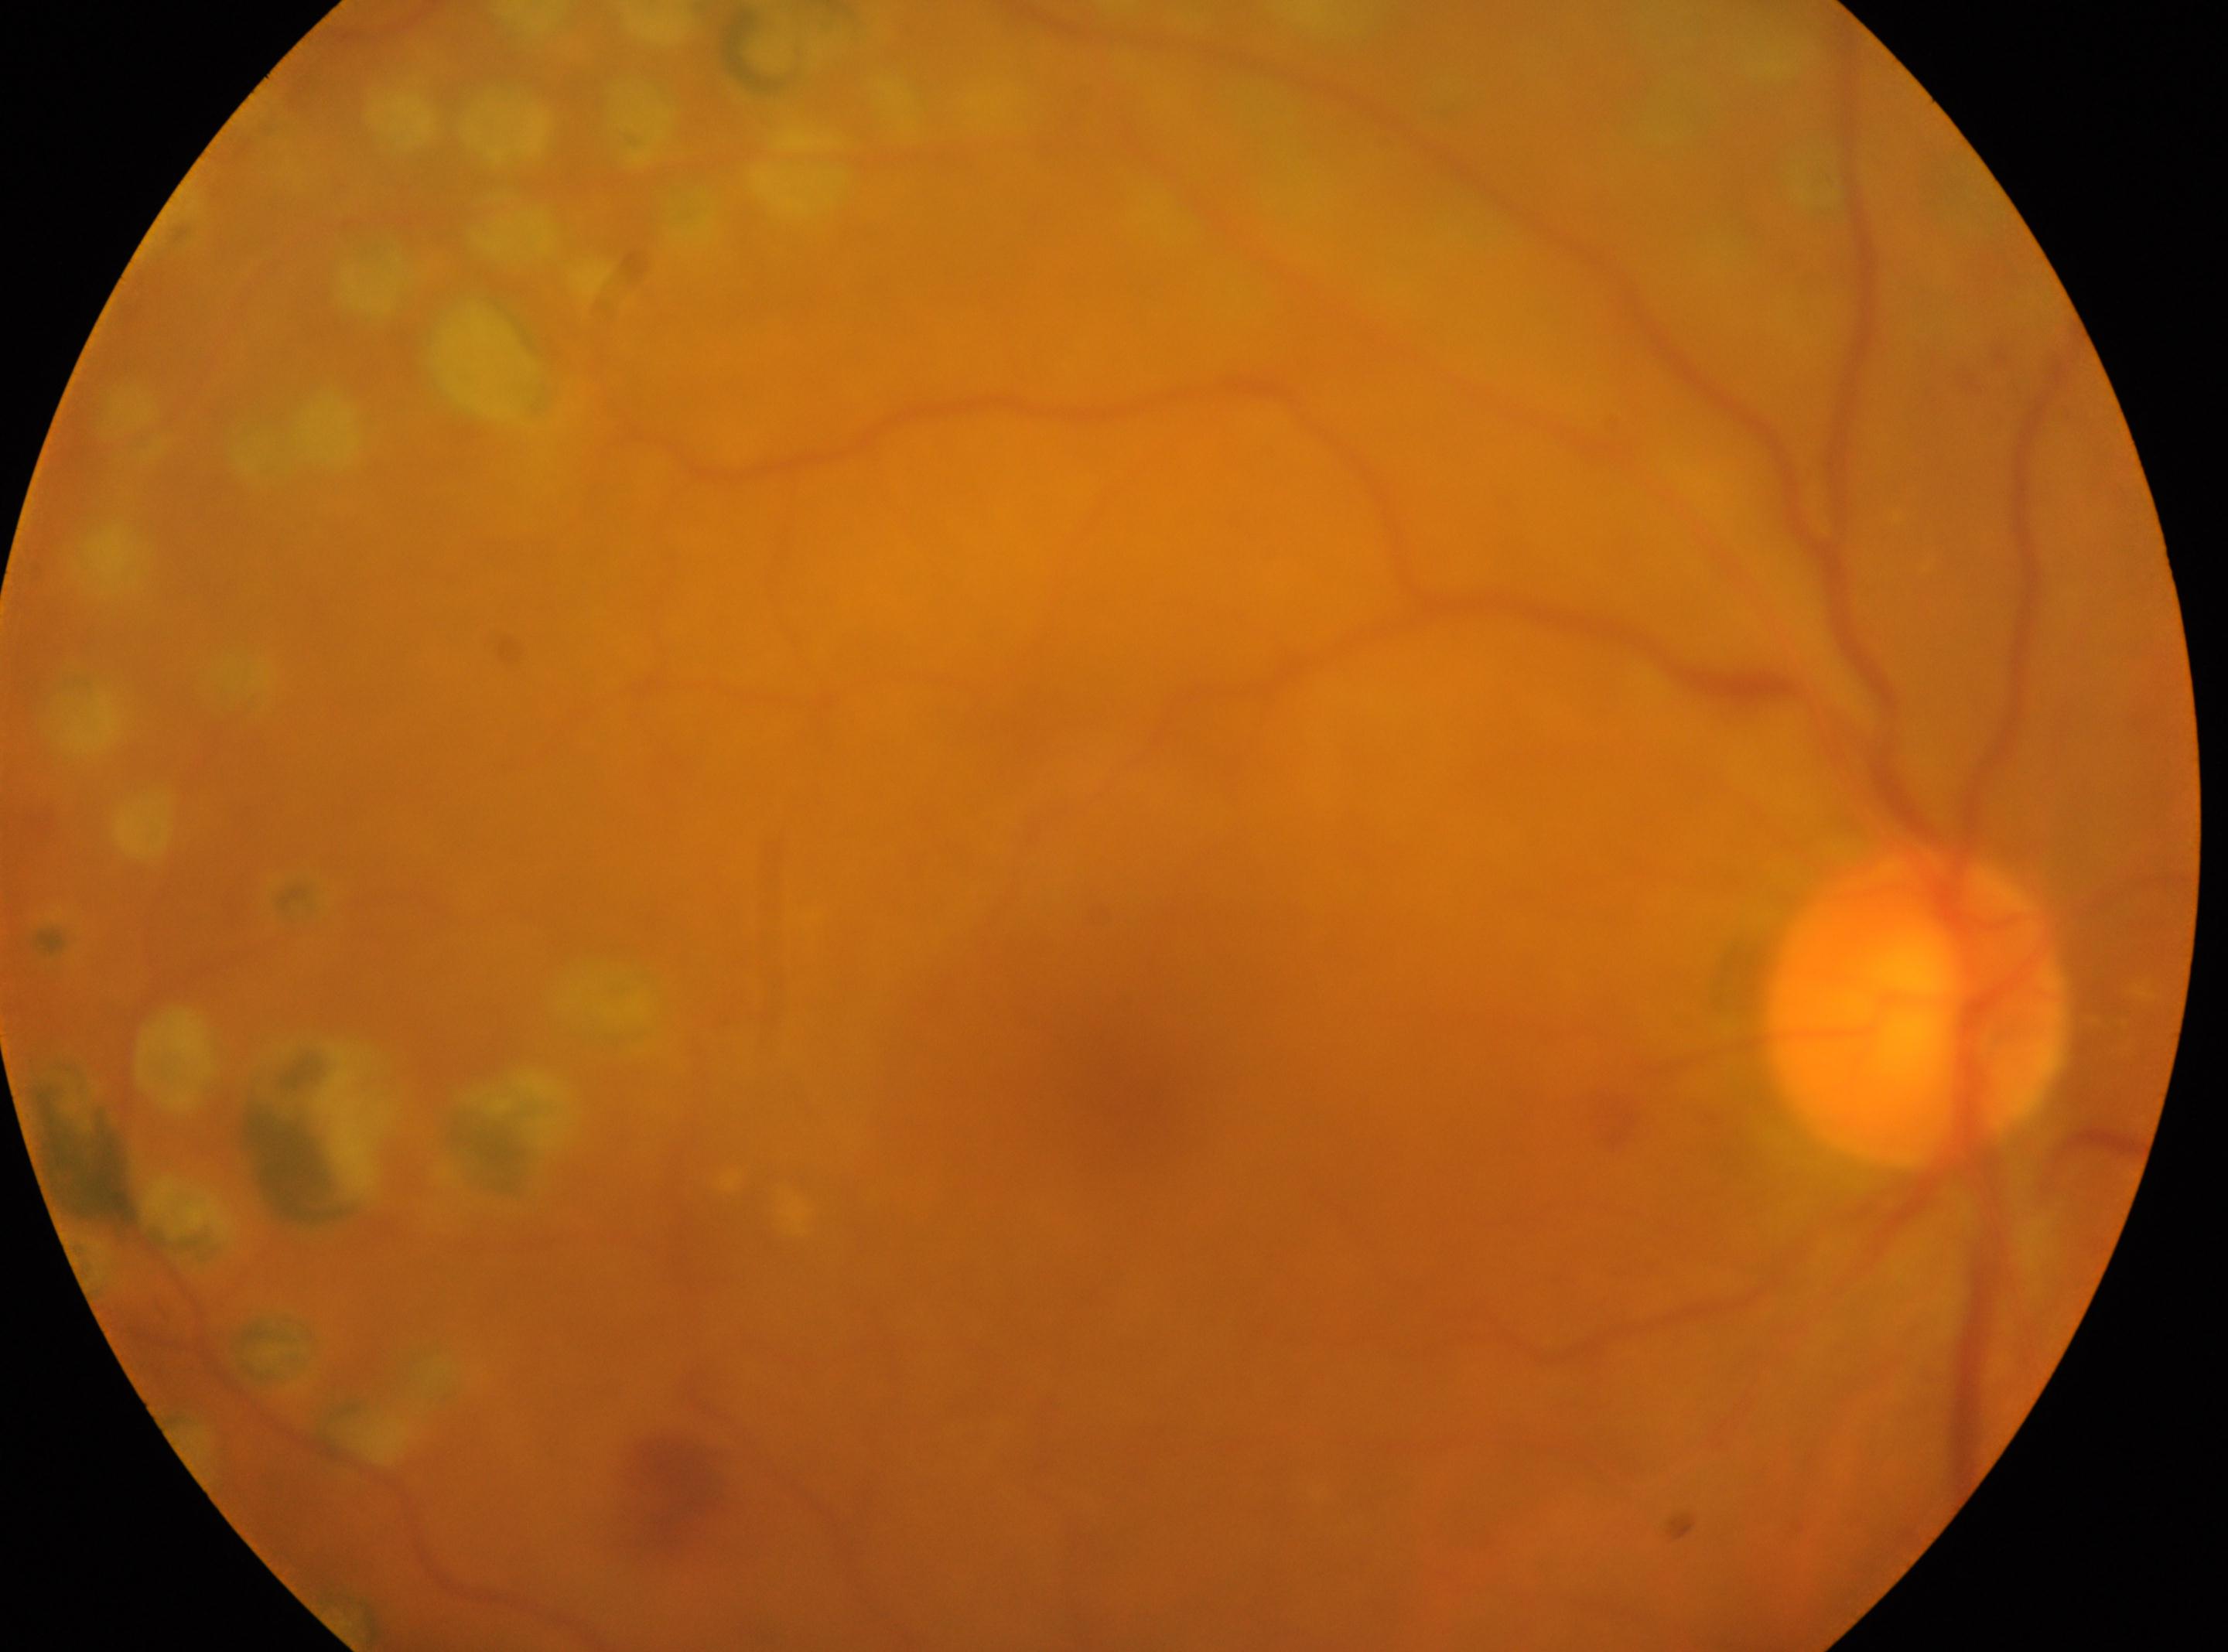

The image shows the right eye. Macular center located at (x=1126, y=1070). DR grade: DR with laser photocoagulation scars. Optic nerve head located at (x=1915, y=1007).